Captured on a Topcon TRC-NW400 fundus camera; 67 years old; axial length: 24.06 mm; corneal thickness: 541 µm:
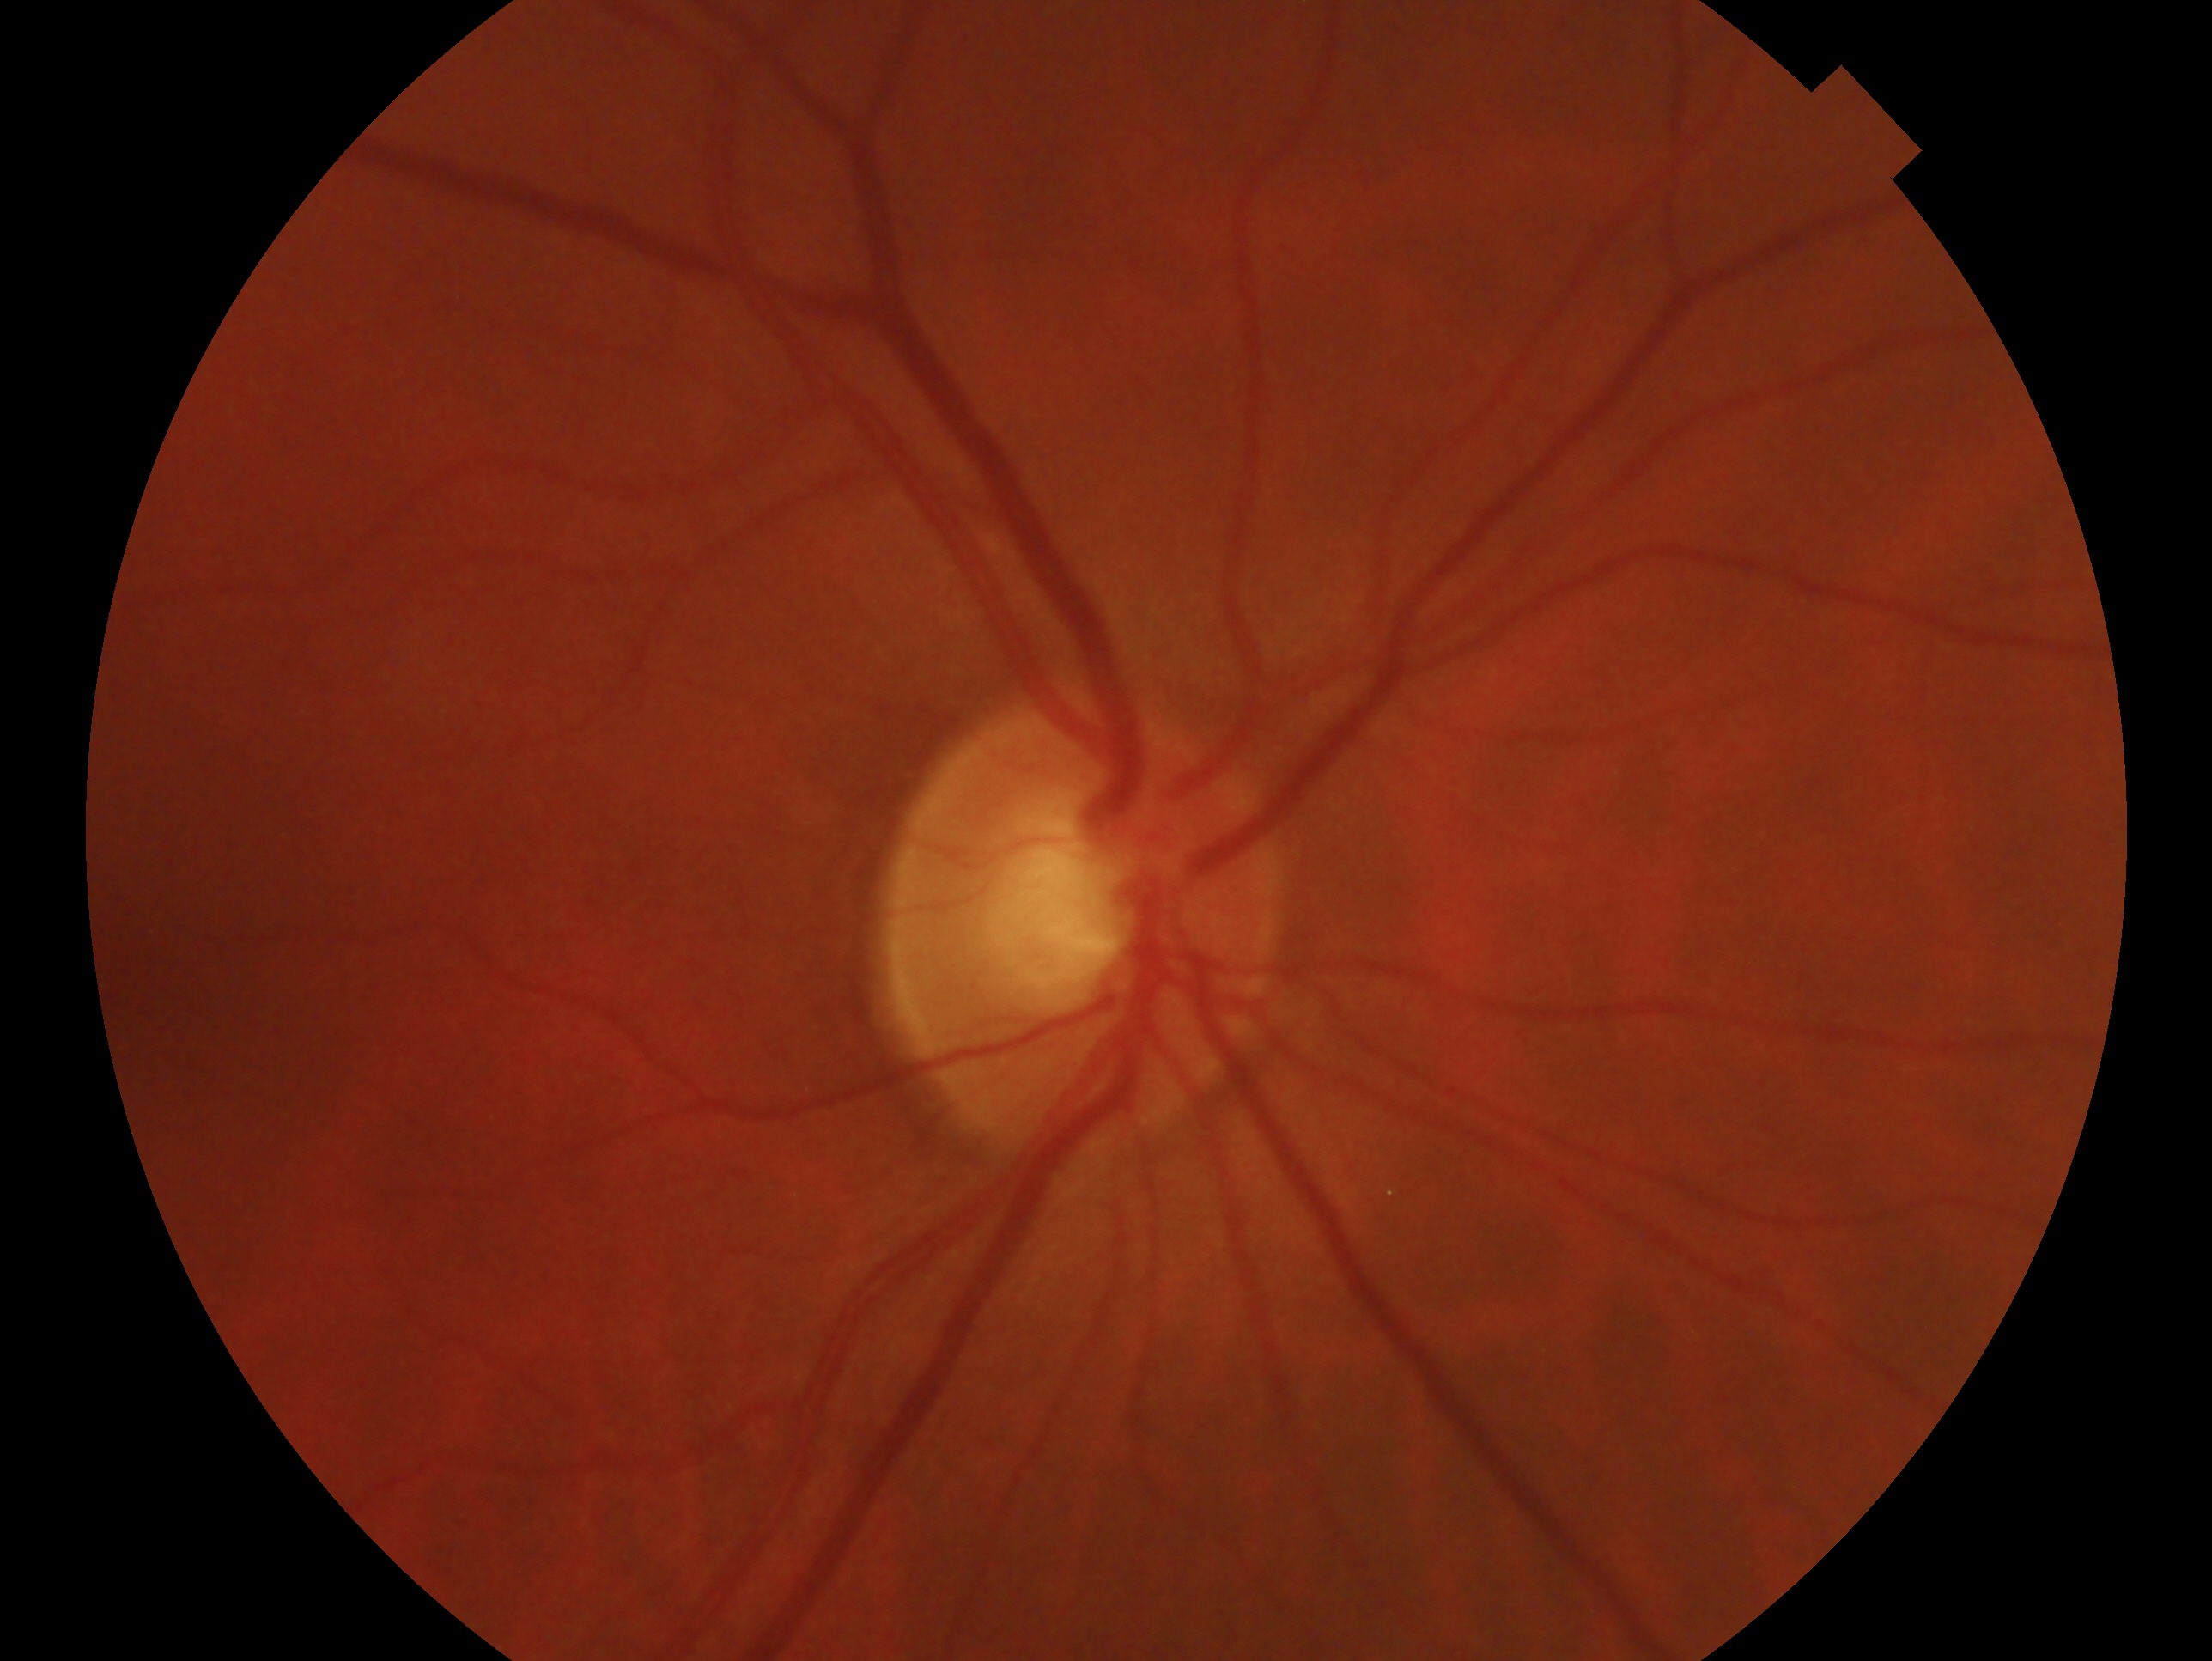 Eye: oculus dexter.
Glaucoma diagnosis: negative for glaucoma.